Ultra-widefield (UWF) fundus image
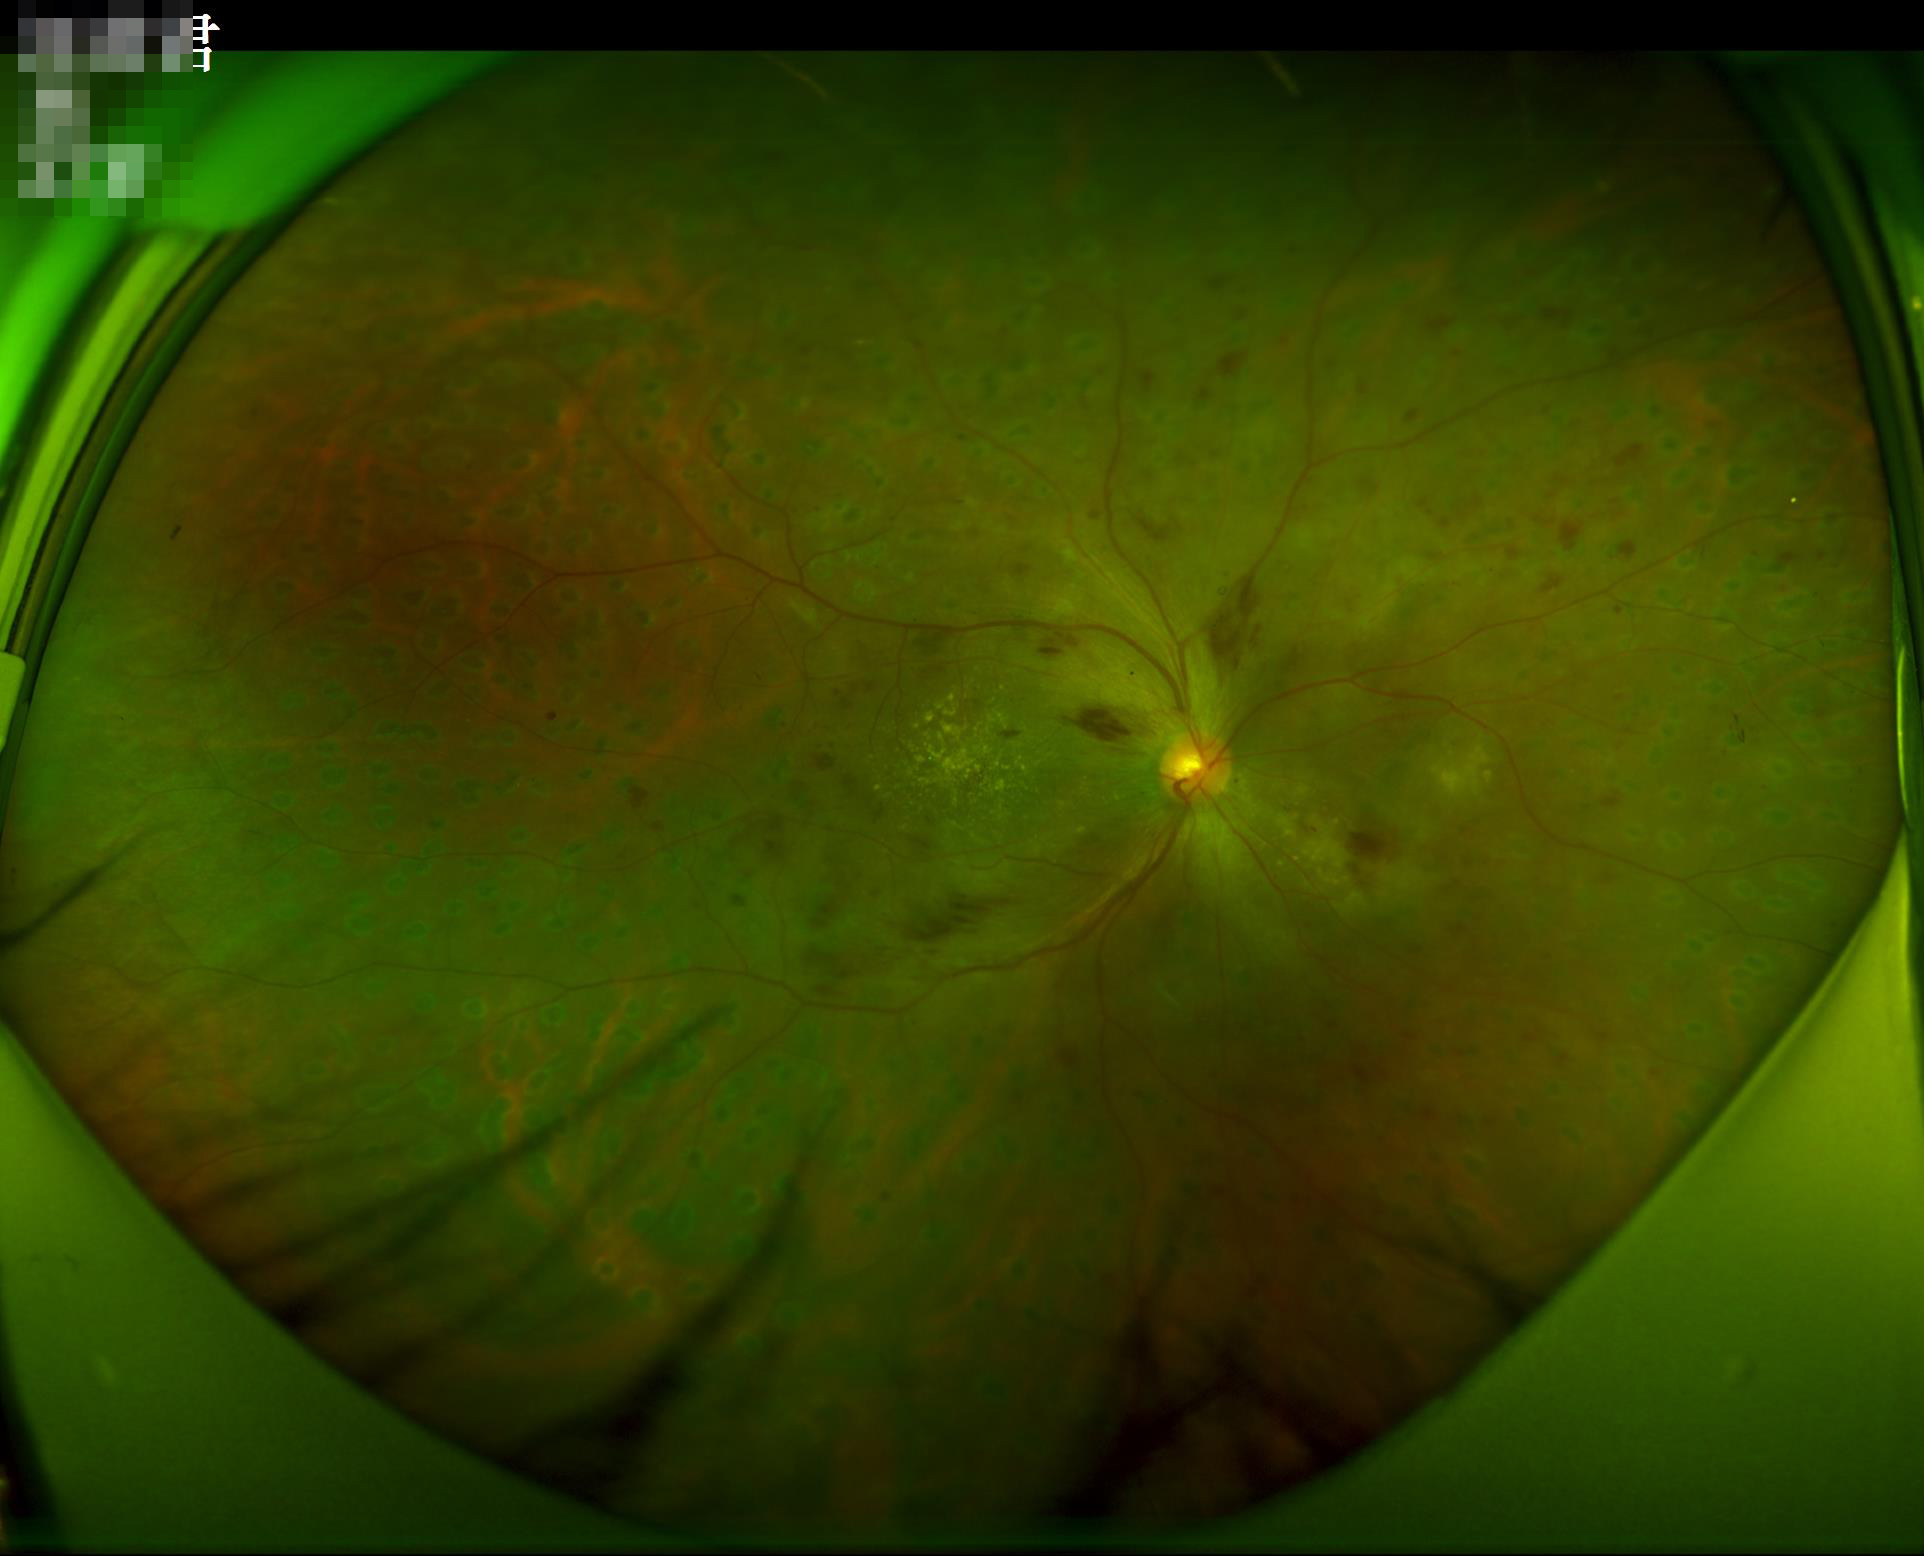

Image quality assessment:
- overall: good and suitable for diagnostic use
- focus: sharp throughout the field
- illumination/color: even and well-balanced
- contrast: wide intensity range, structures distinguishable